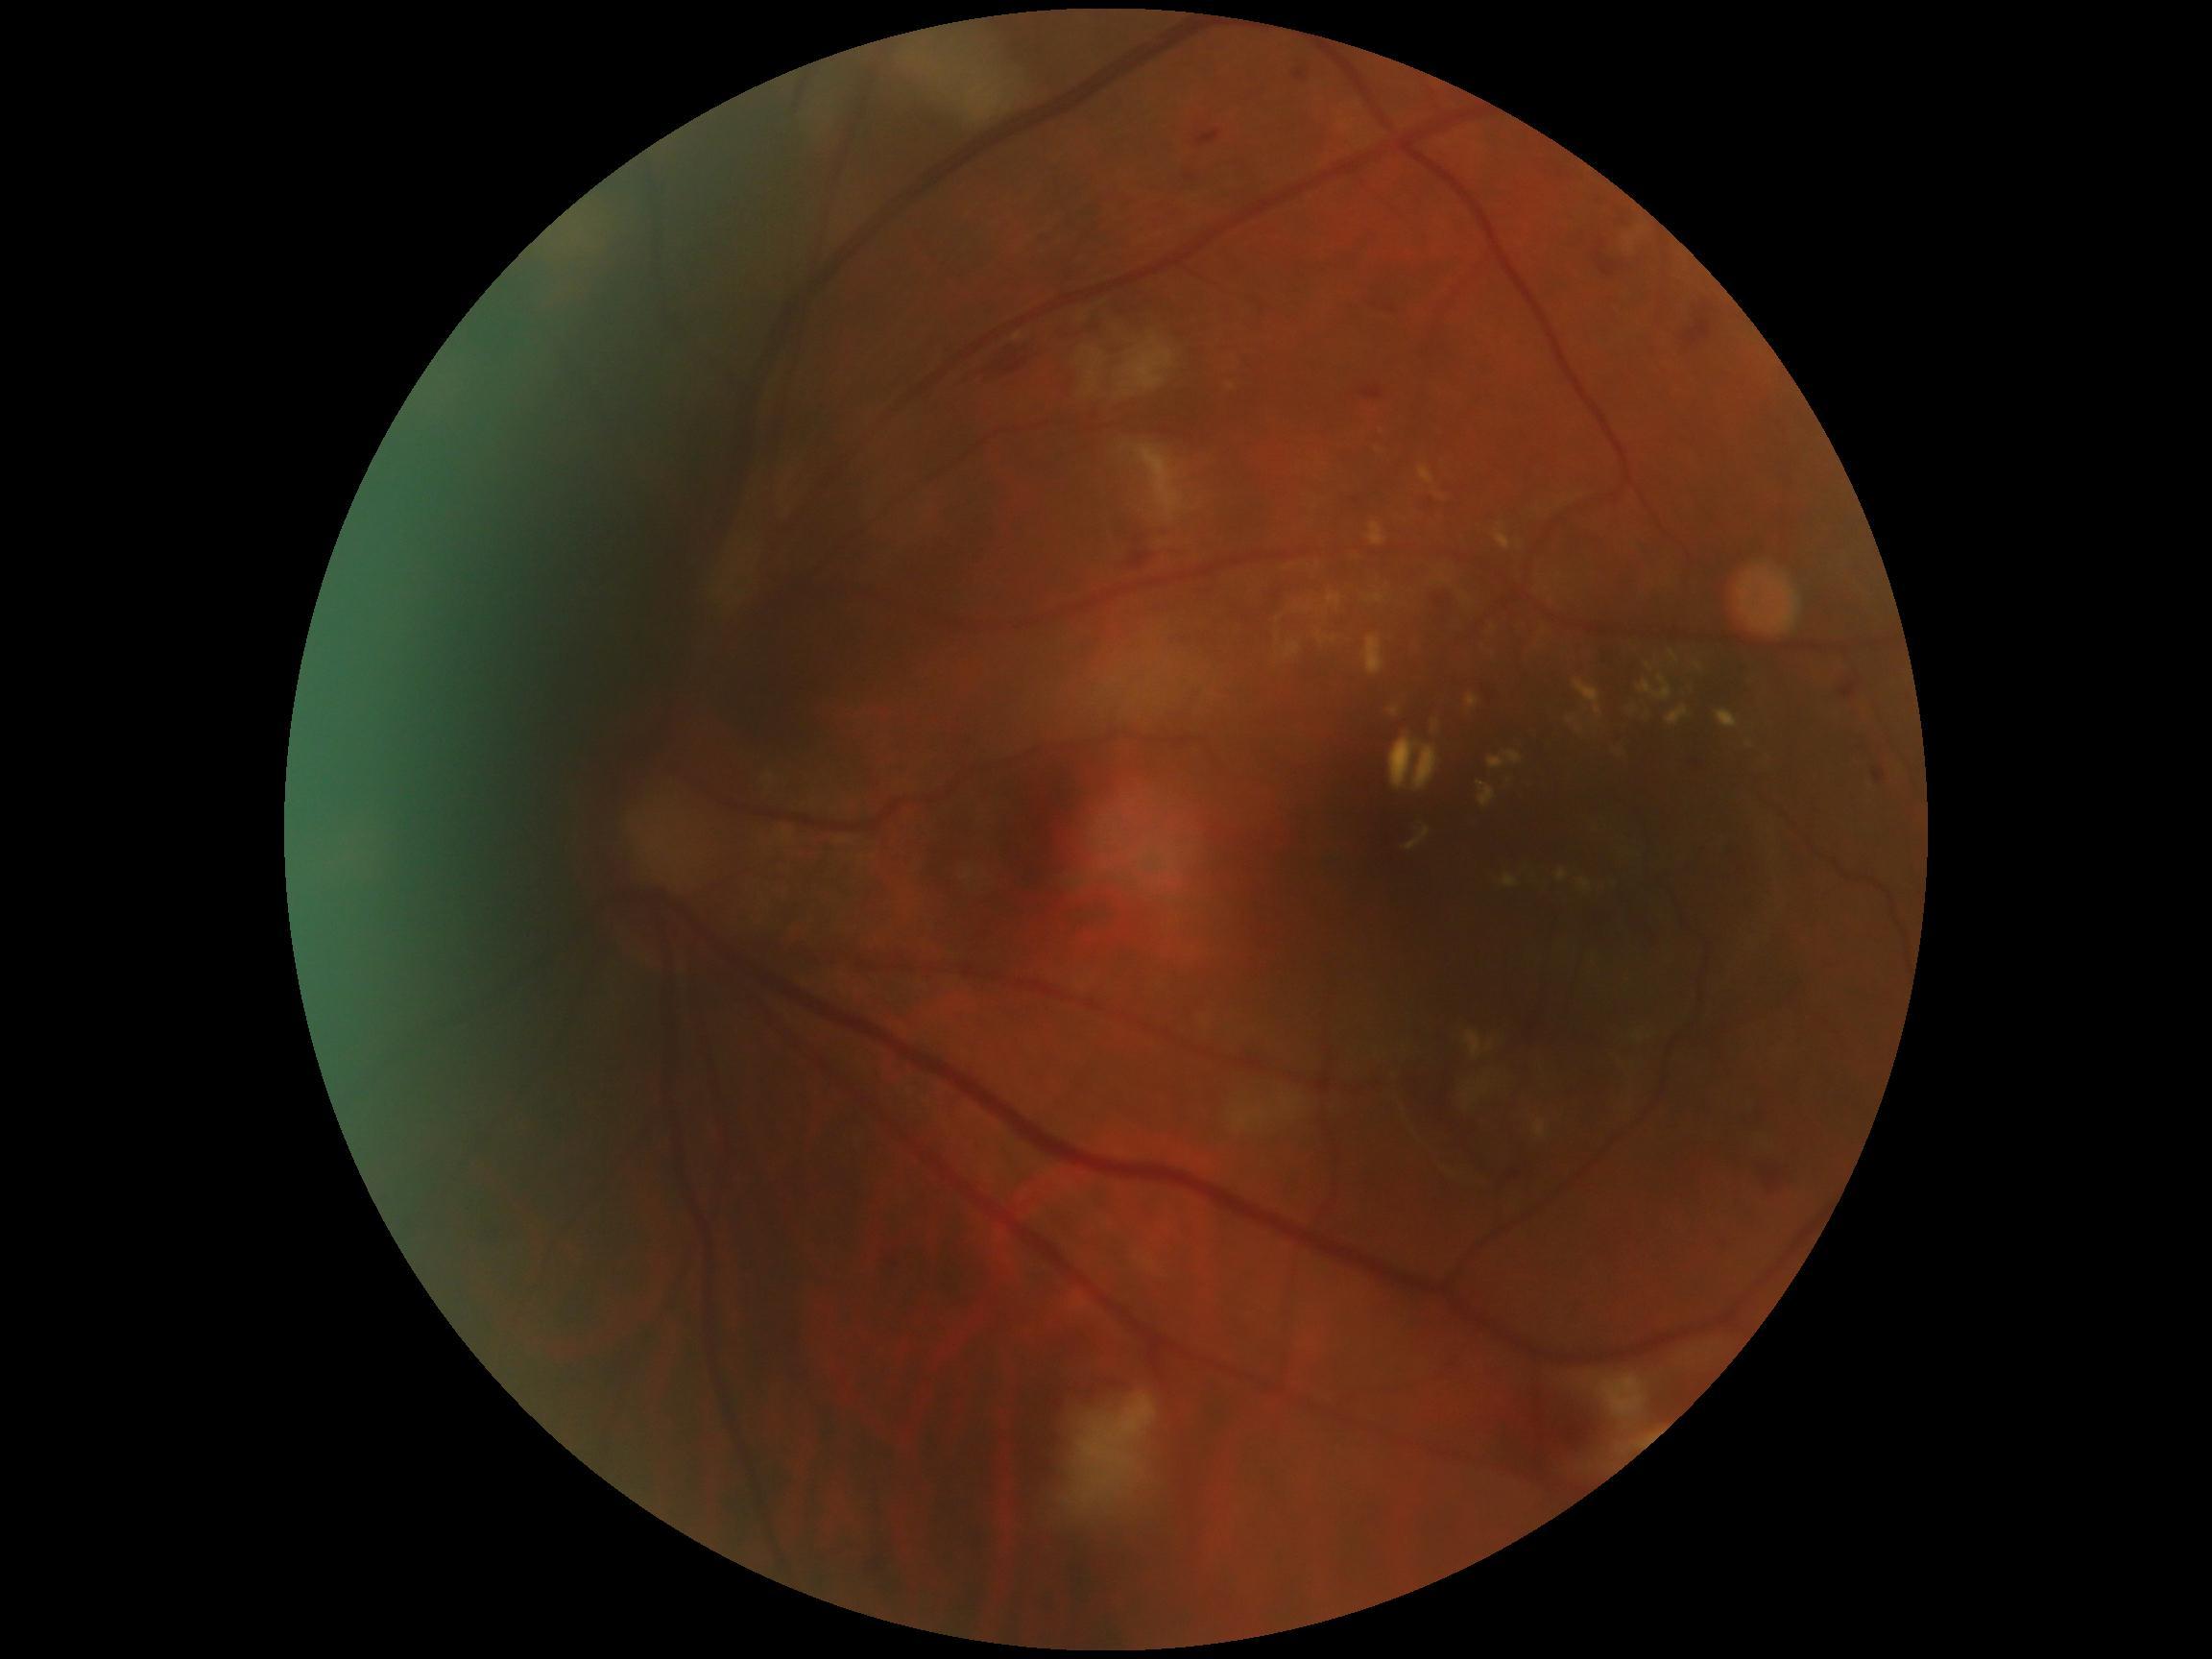
DR grade is 2.